Fundus photo taken with a portable handheld camera · 2212x1659:
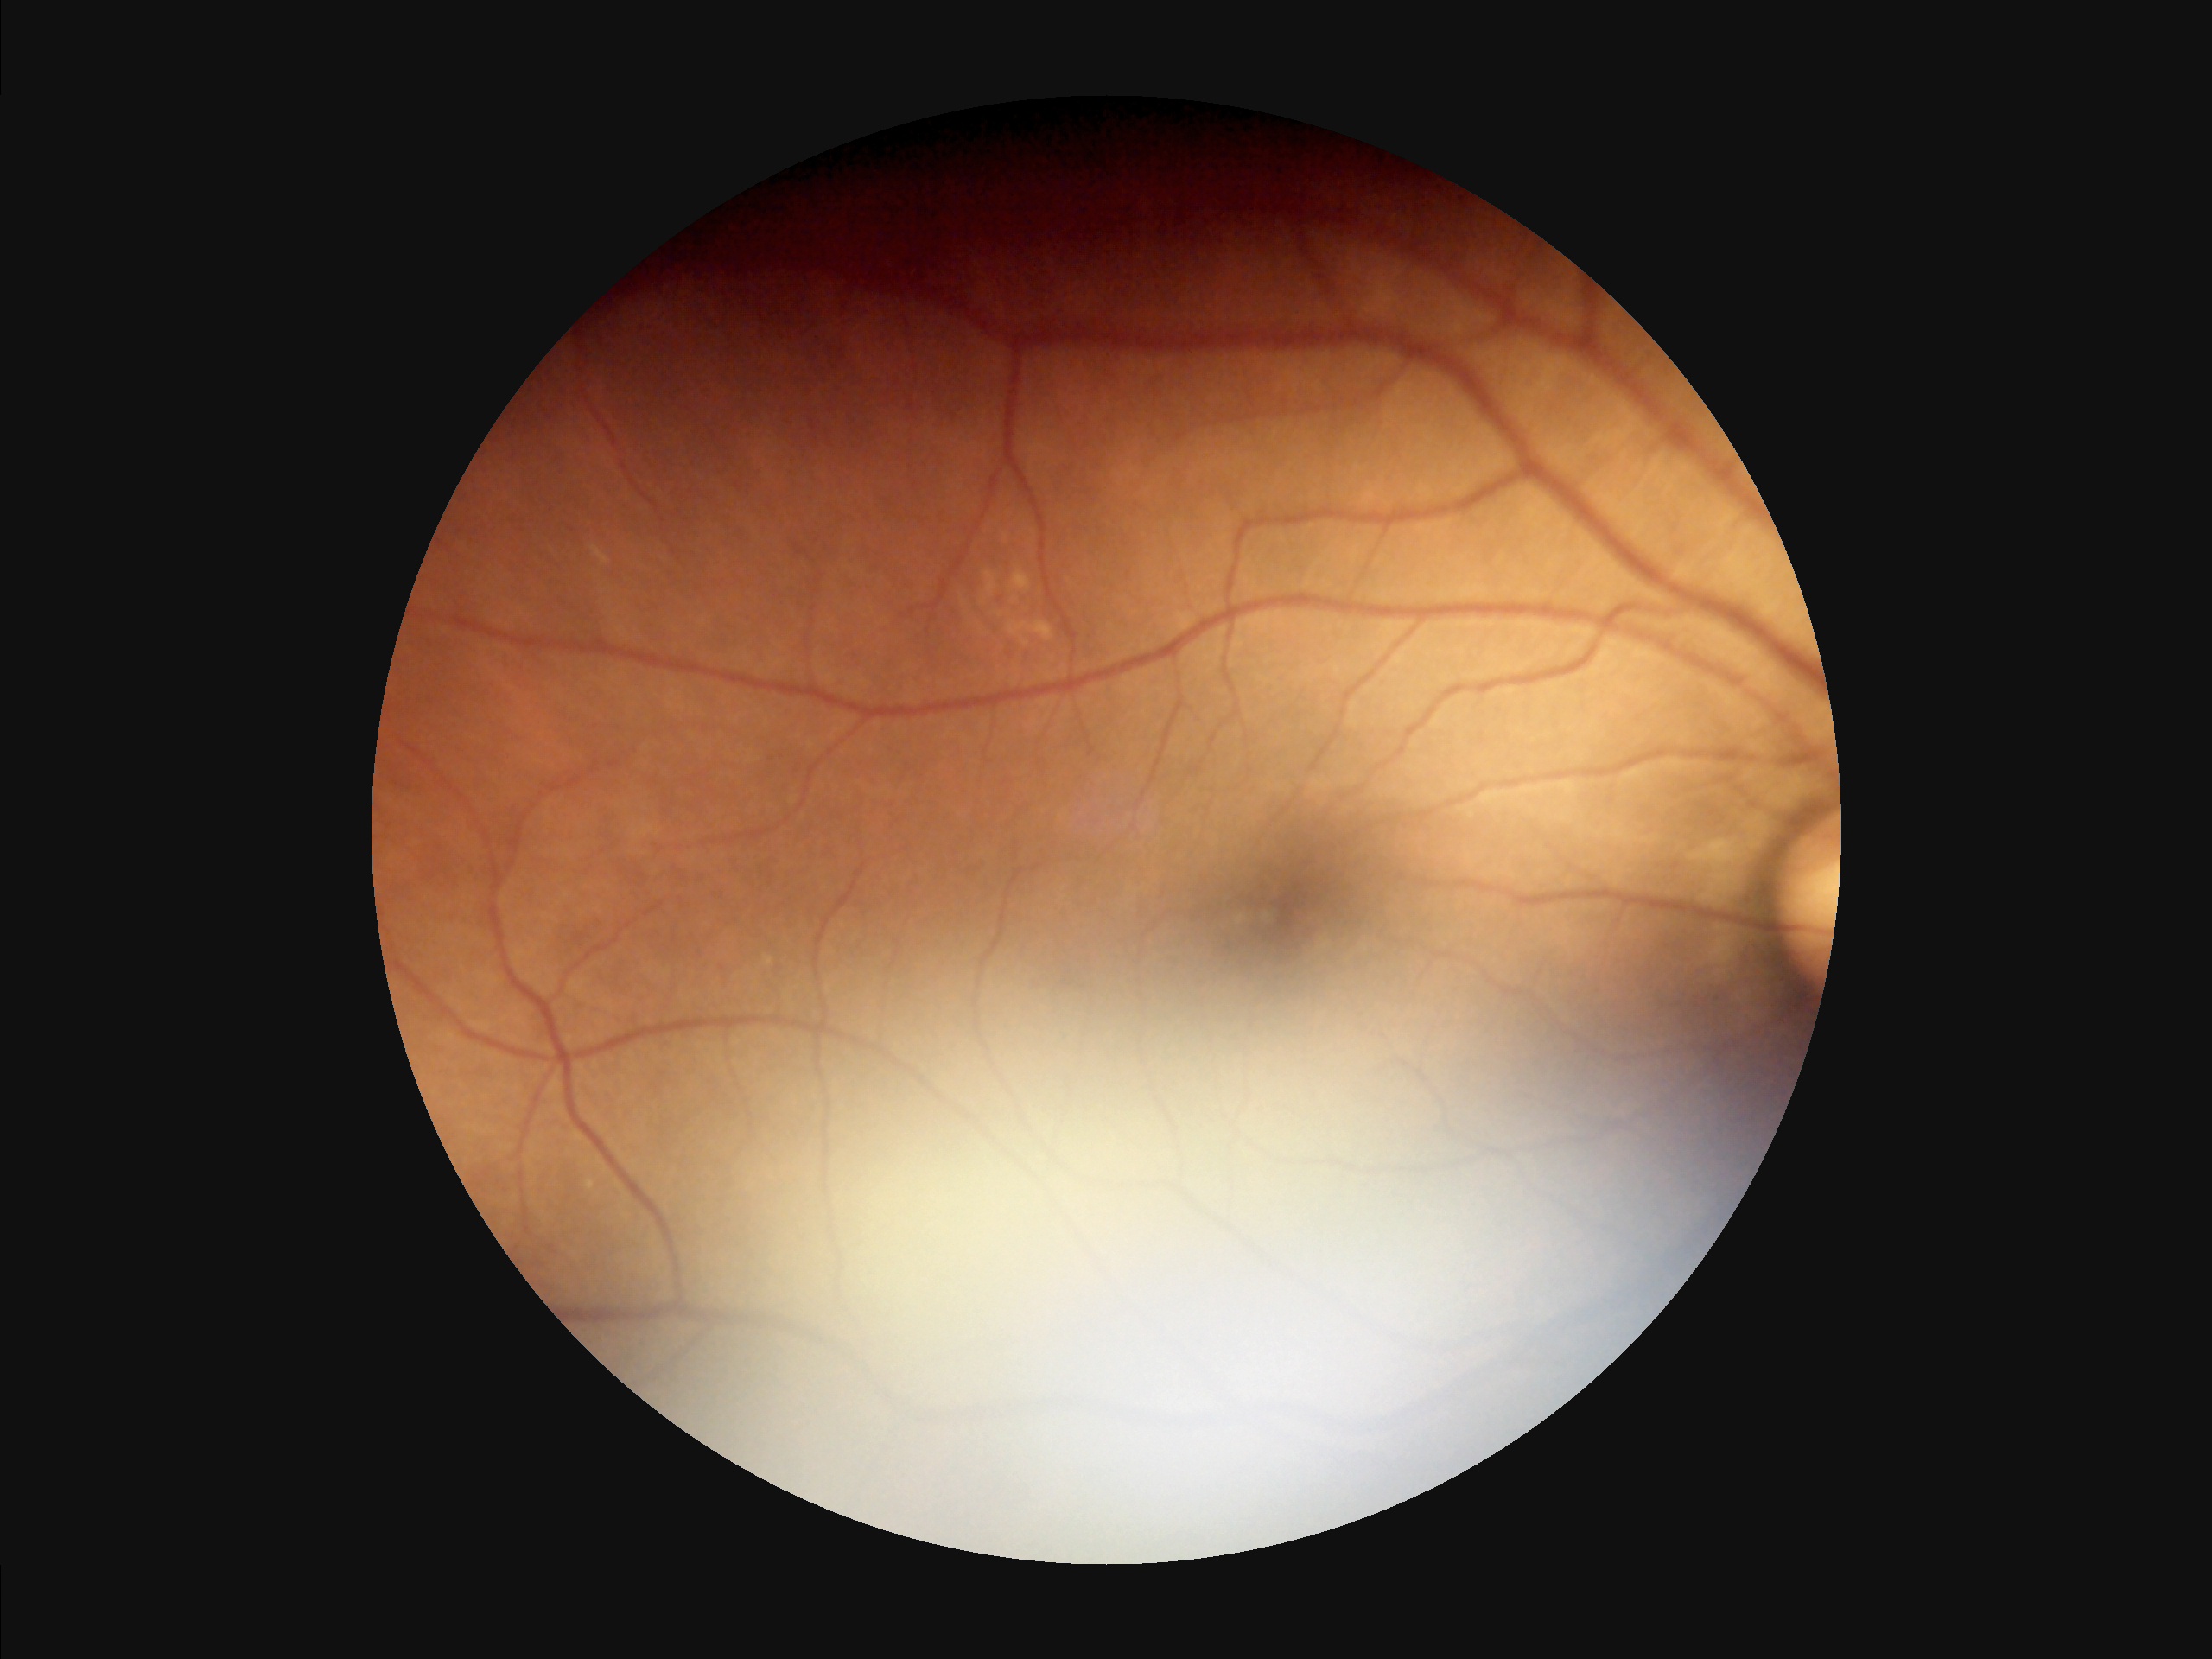 Overall quality is poor; the image is difficult to grade.
Vessels and details are readily distinguishable.
Poor illumination with uneven exposure.
Out of focus; structures are indistinct.